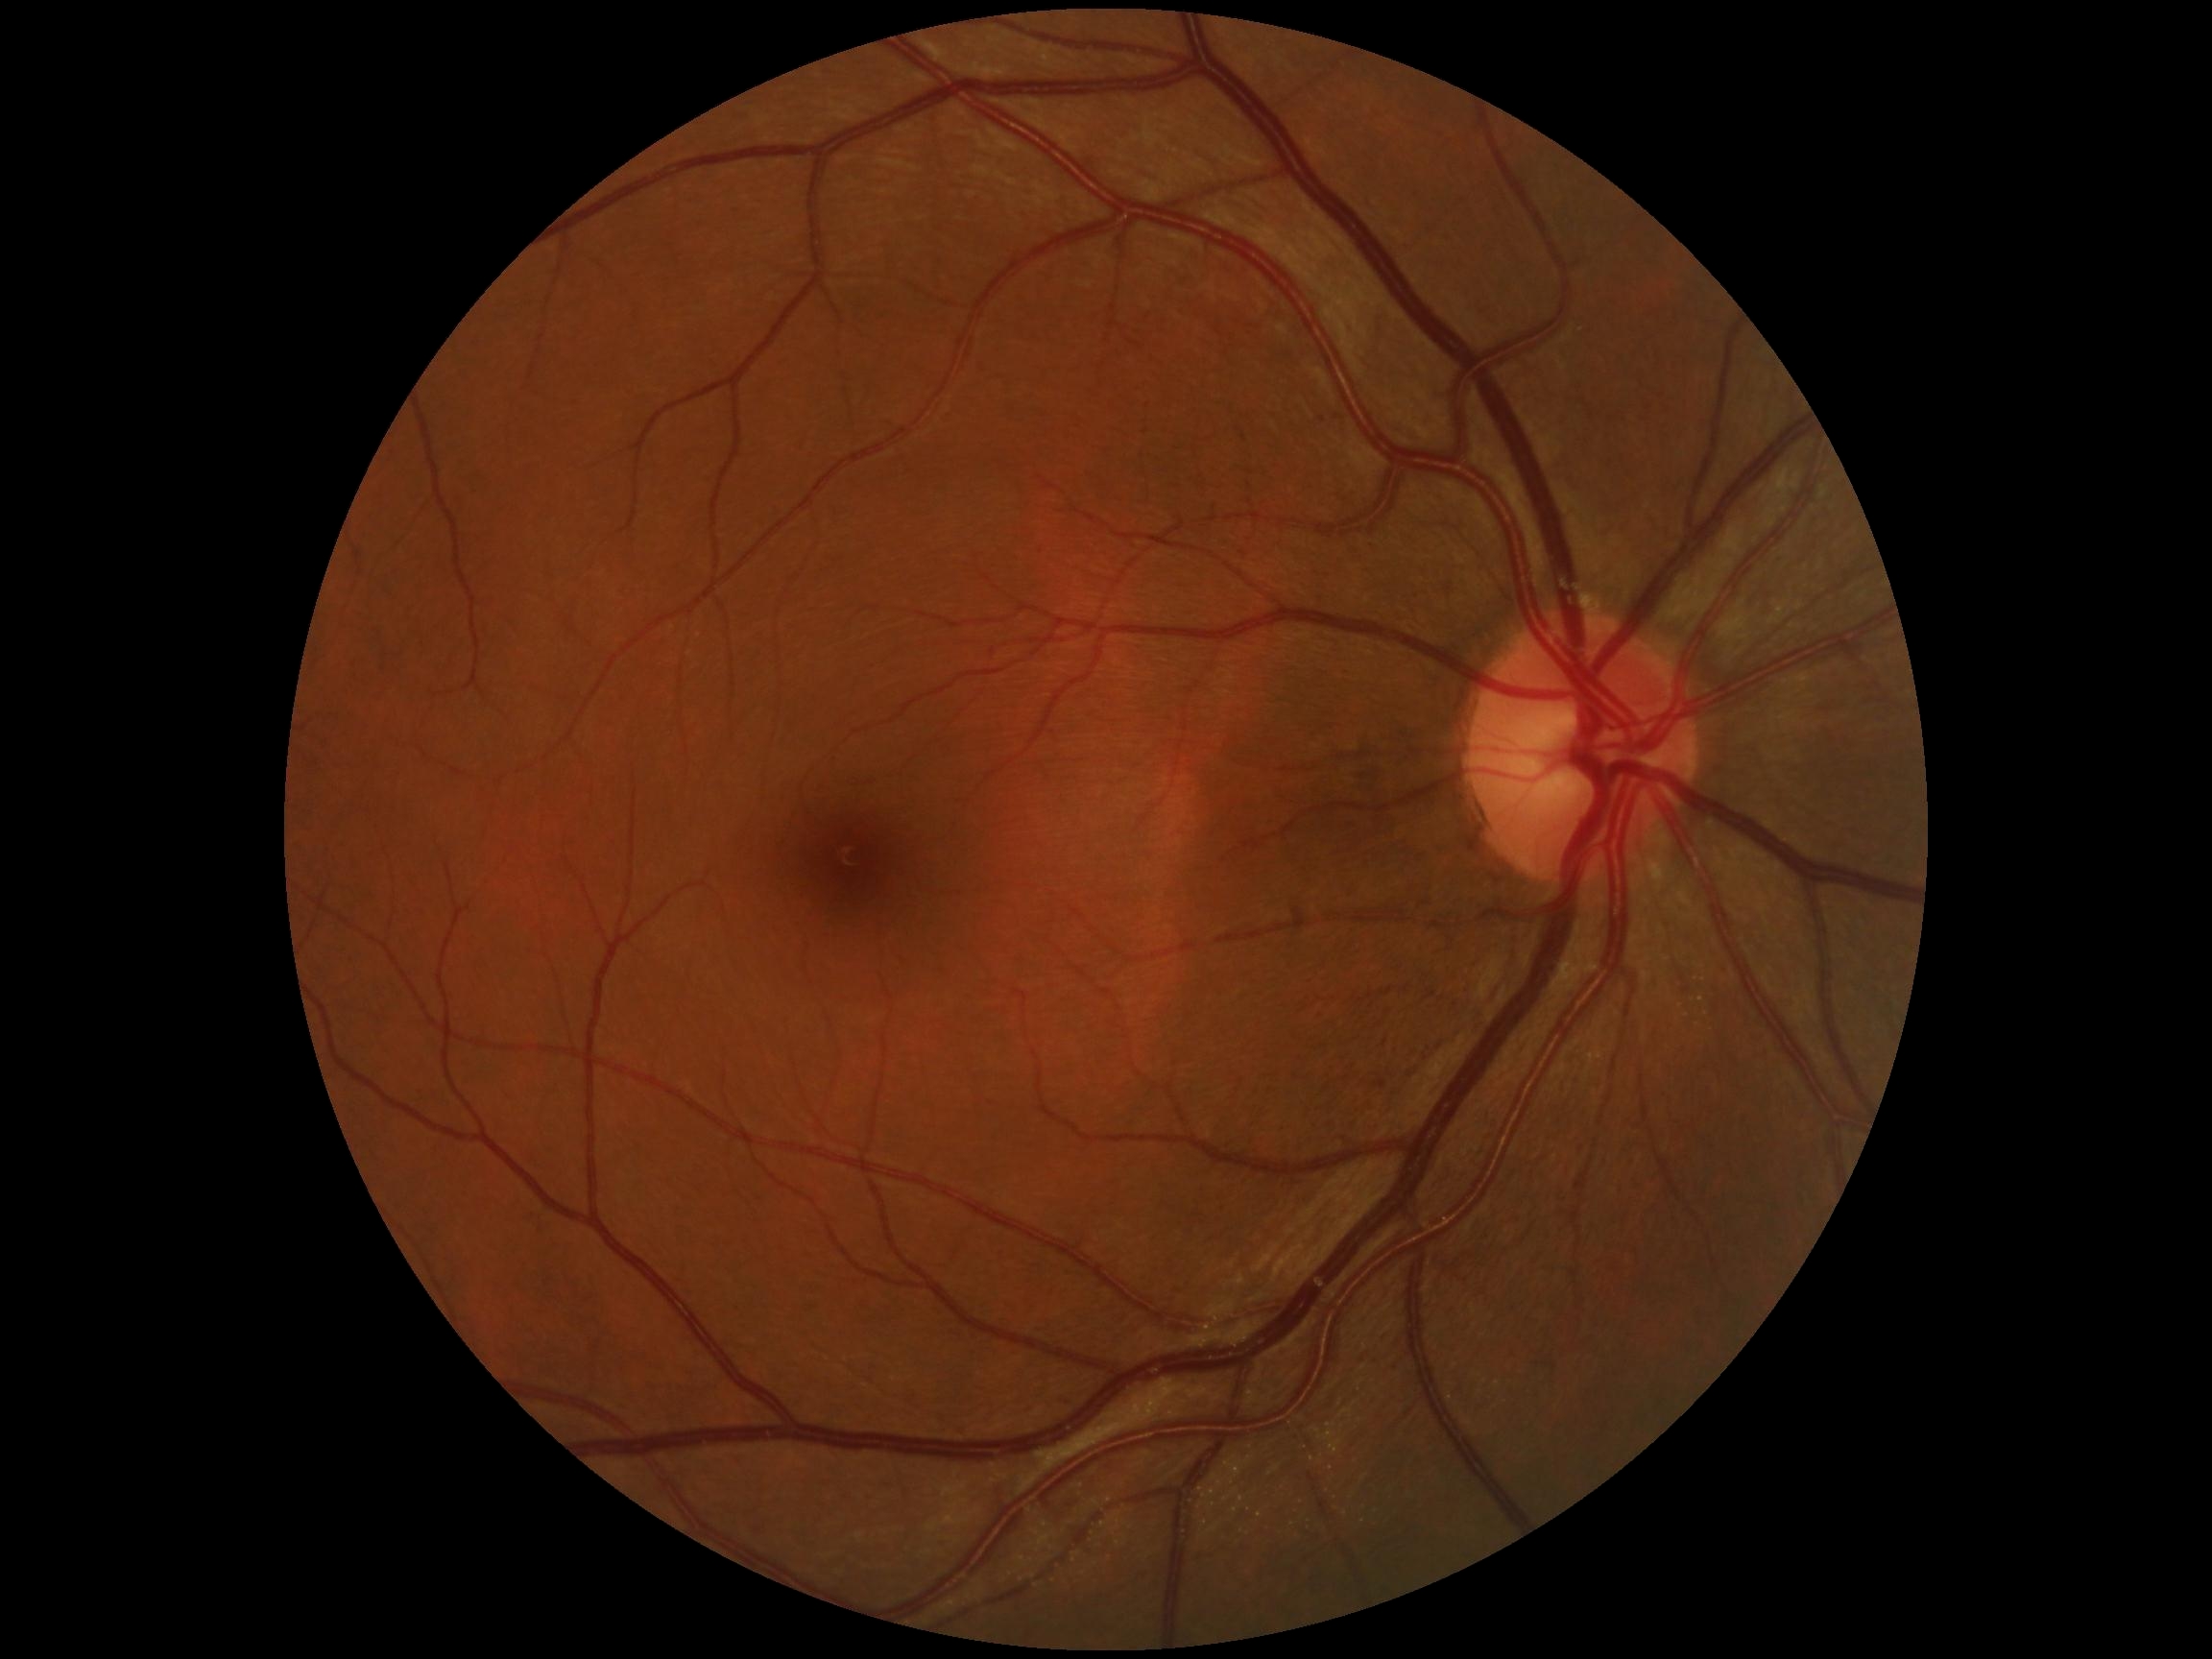
diabetic retinopathy grade = 0/4.